Wide-field fundus photograph of an infant · 1240 by 1240 pixels:
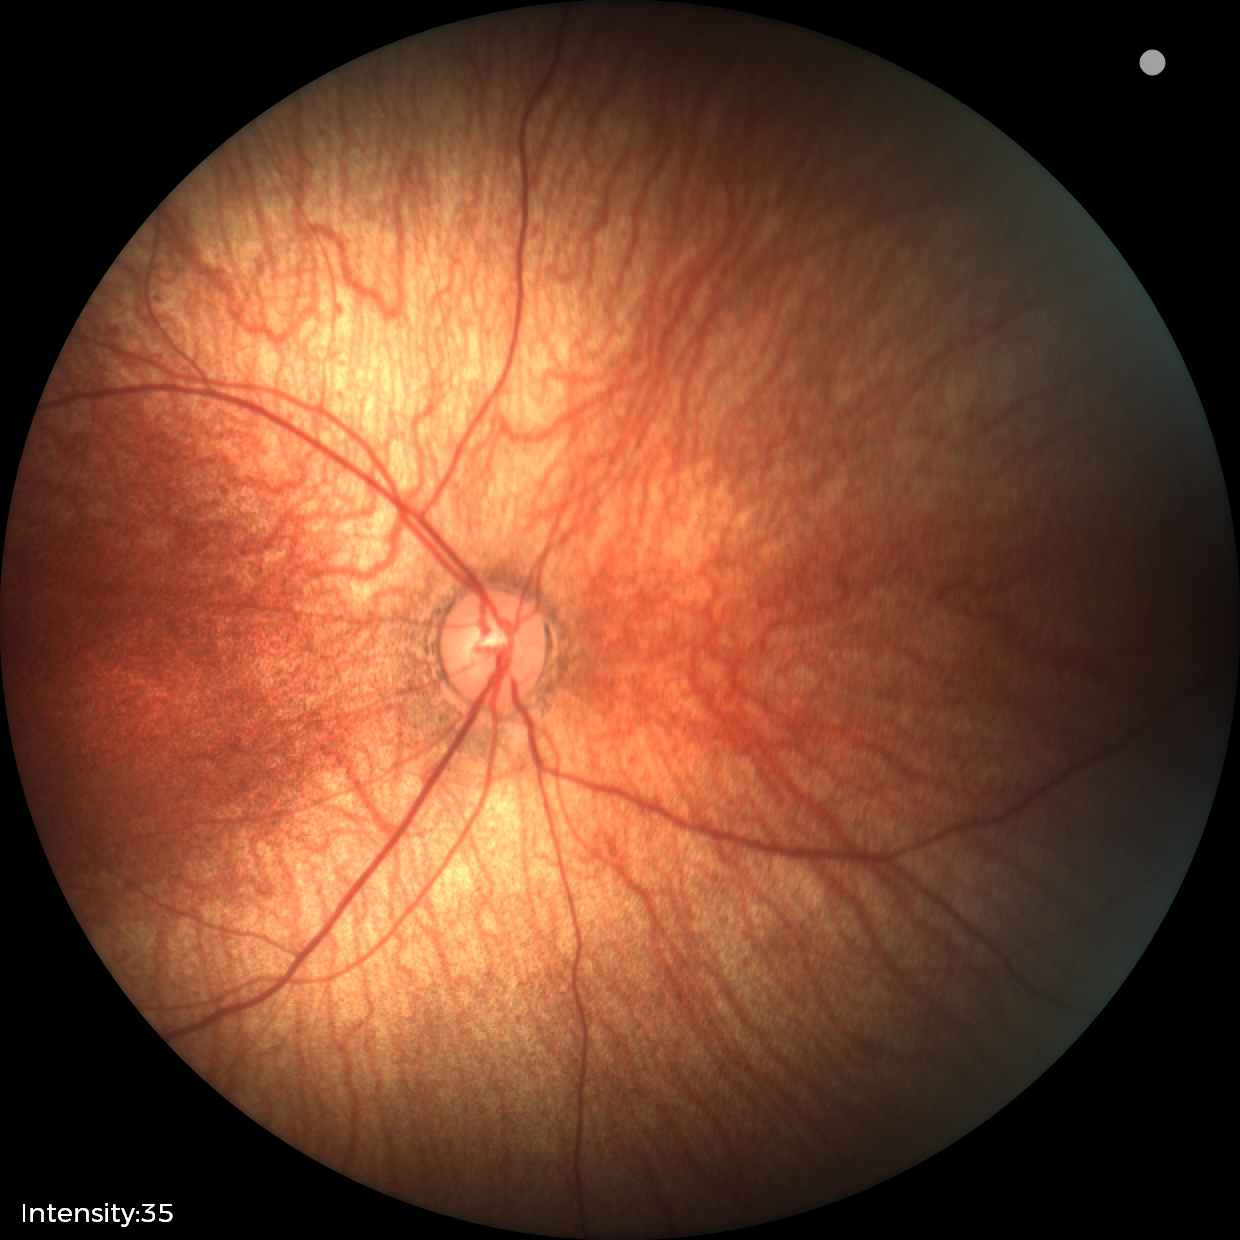
No retinal pathology identified on screening.